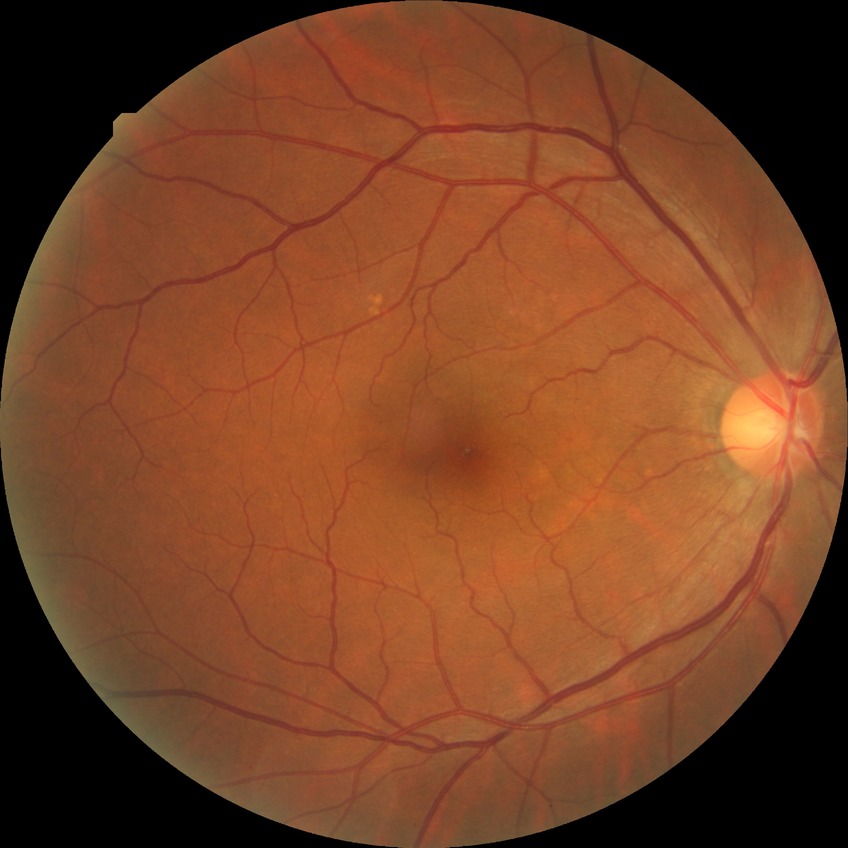

Davis grading: no diabetic retinopathy.